Phoenix ICON wide-field infant fundus image; 100° field of view (Phoenix ICON):
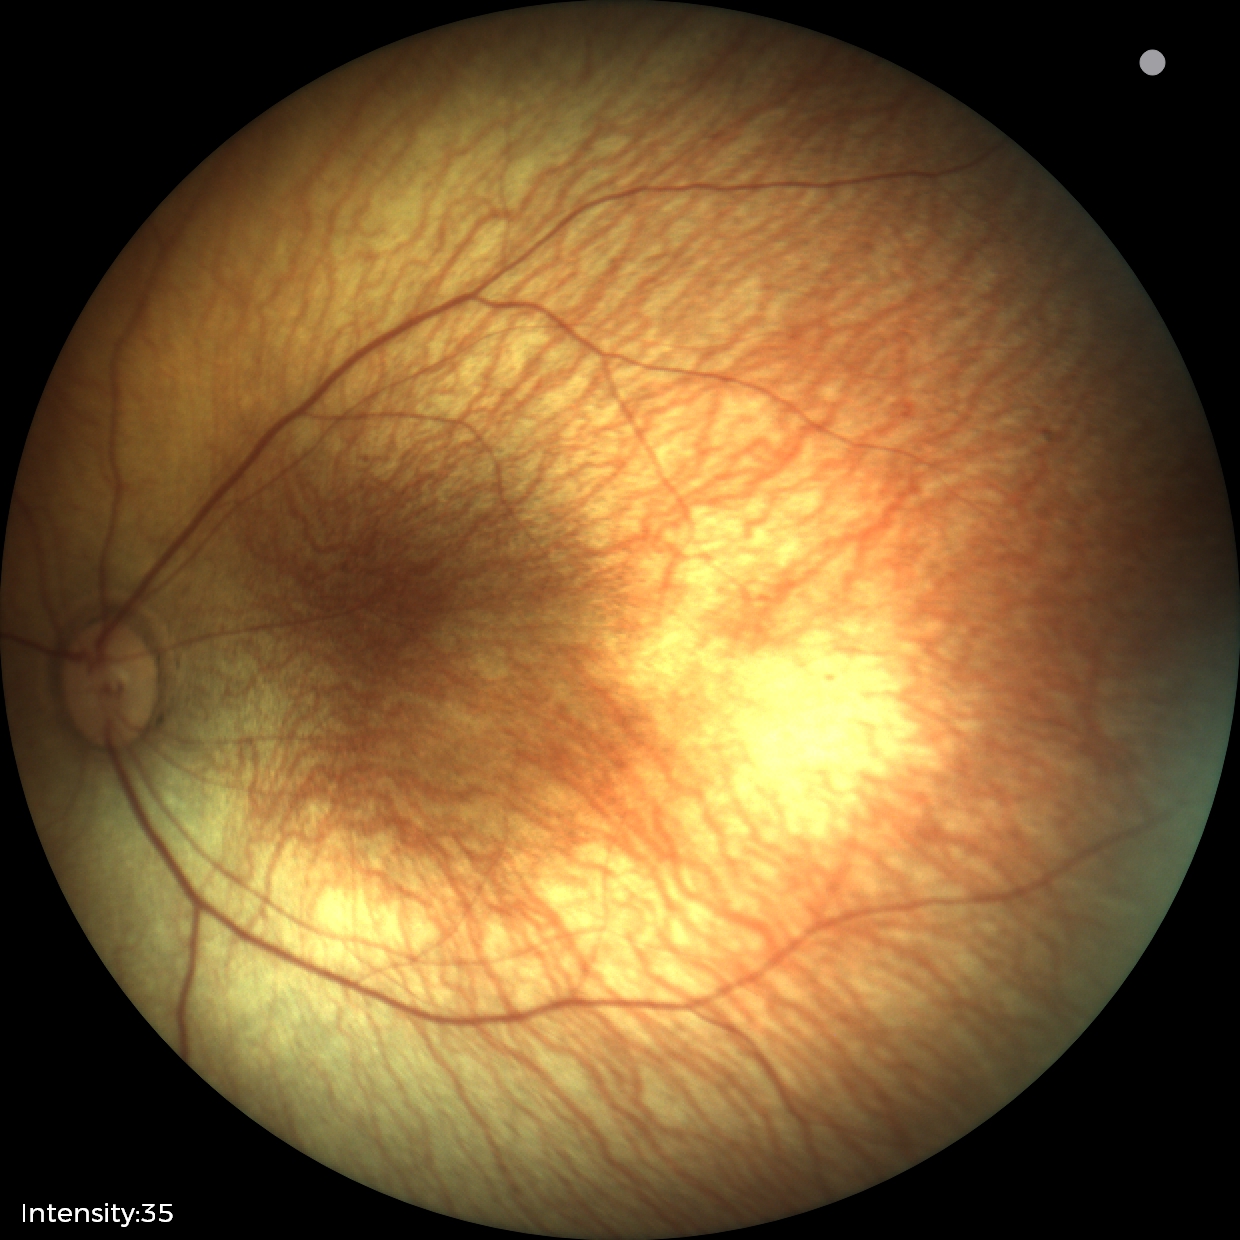

Normal screening examination.